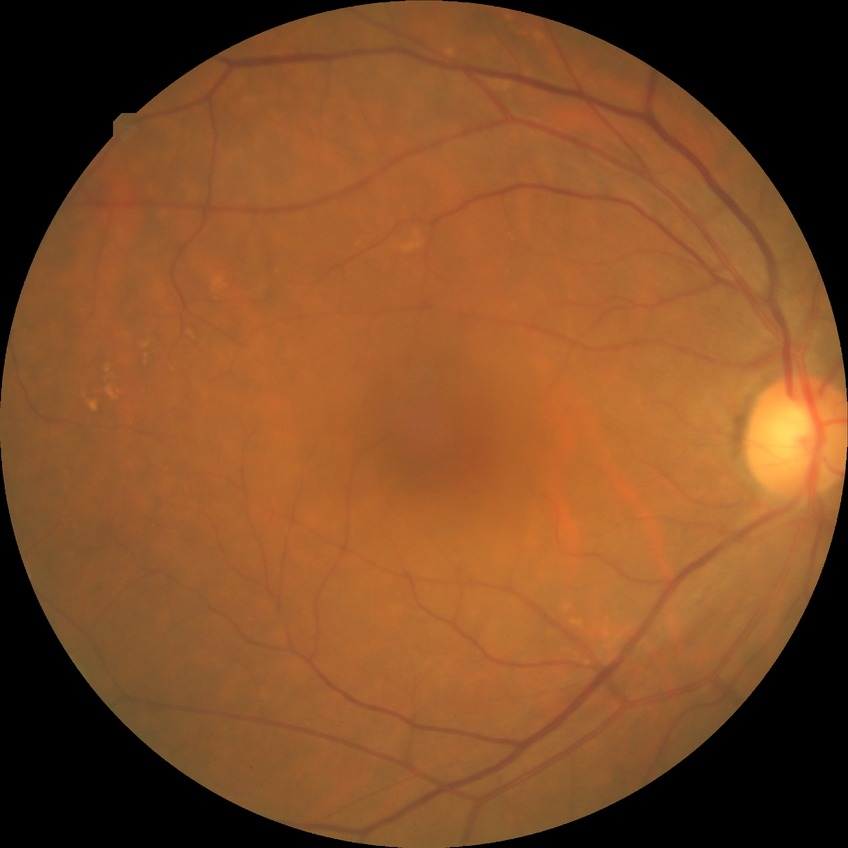 Assessment:
- diabetic retinopathy (DR) — NDR (no diabetic retinopathy)